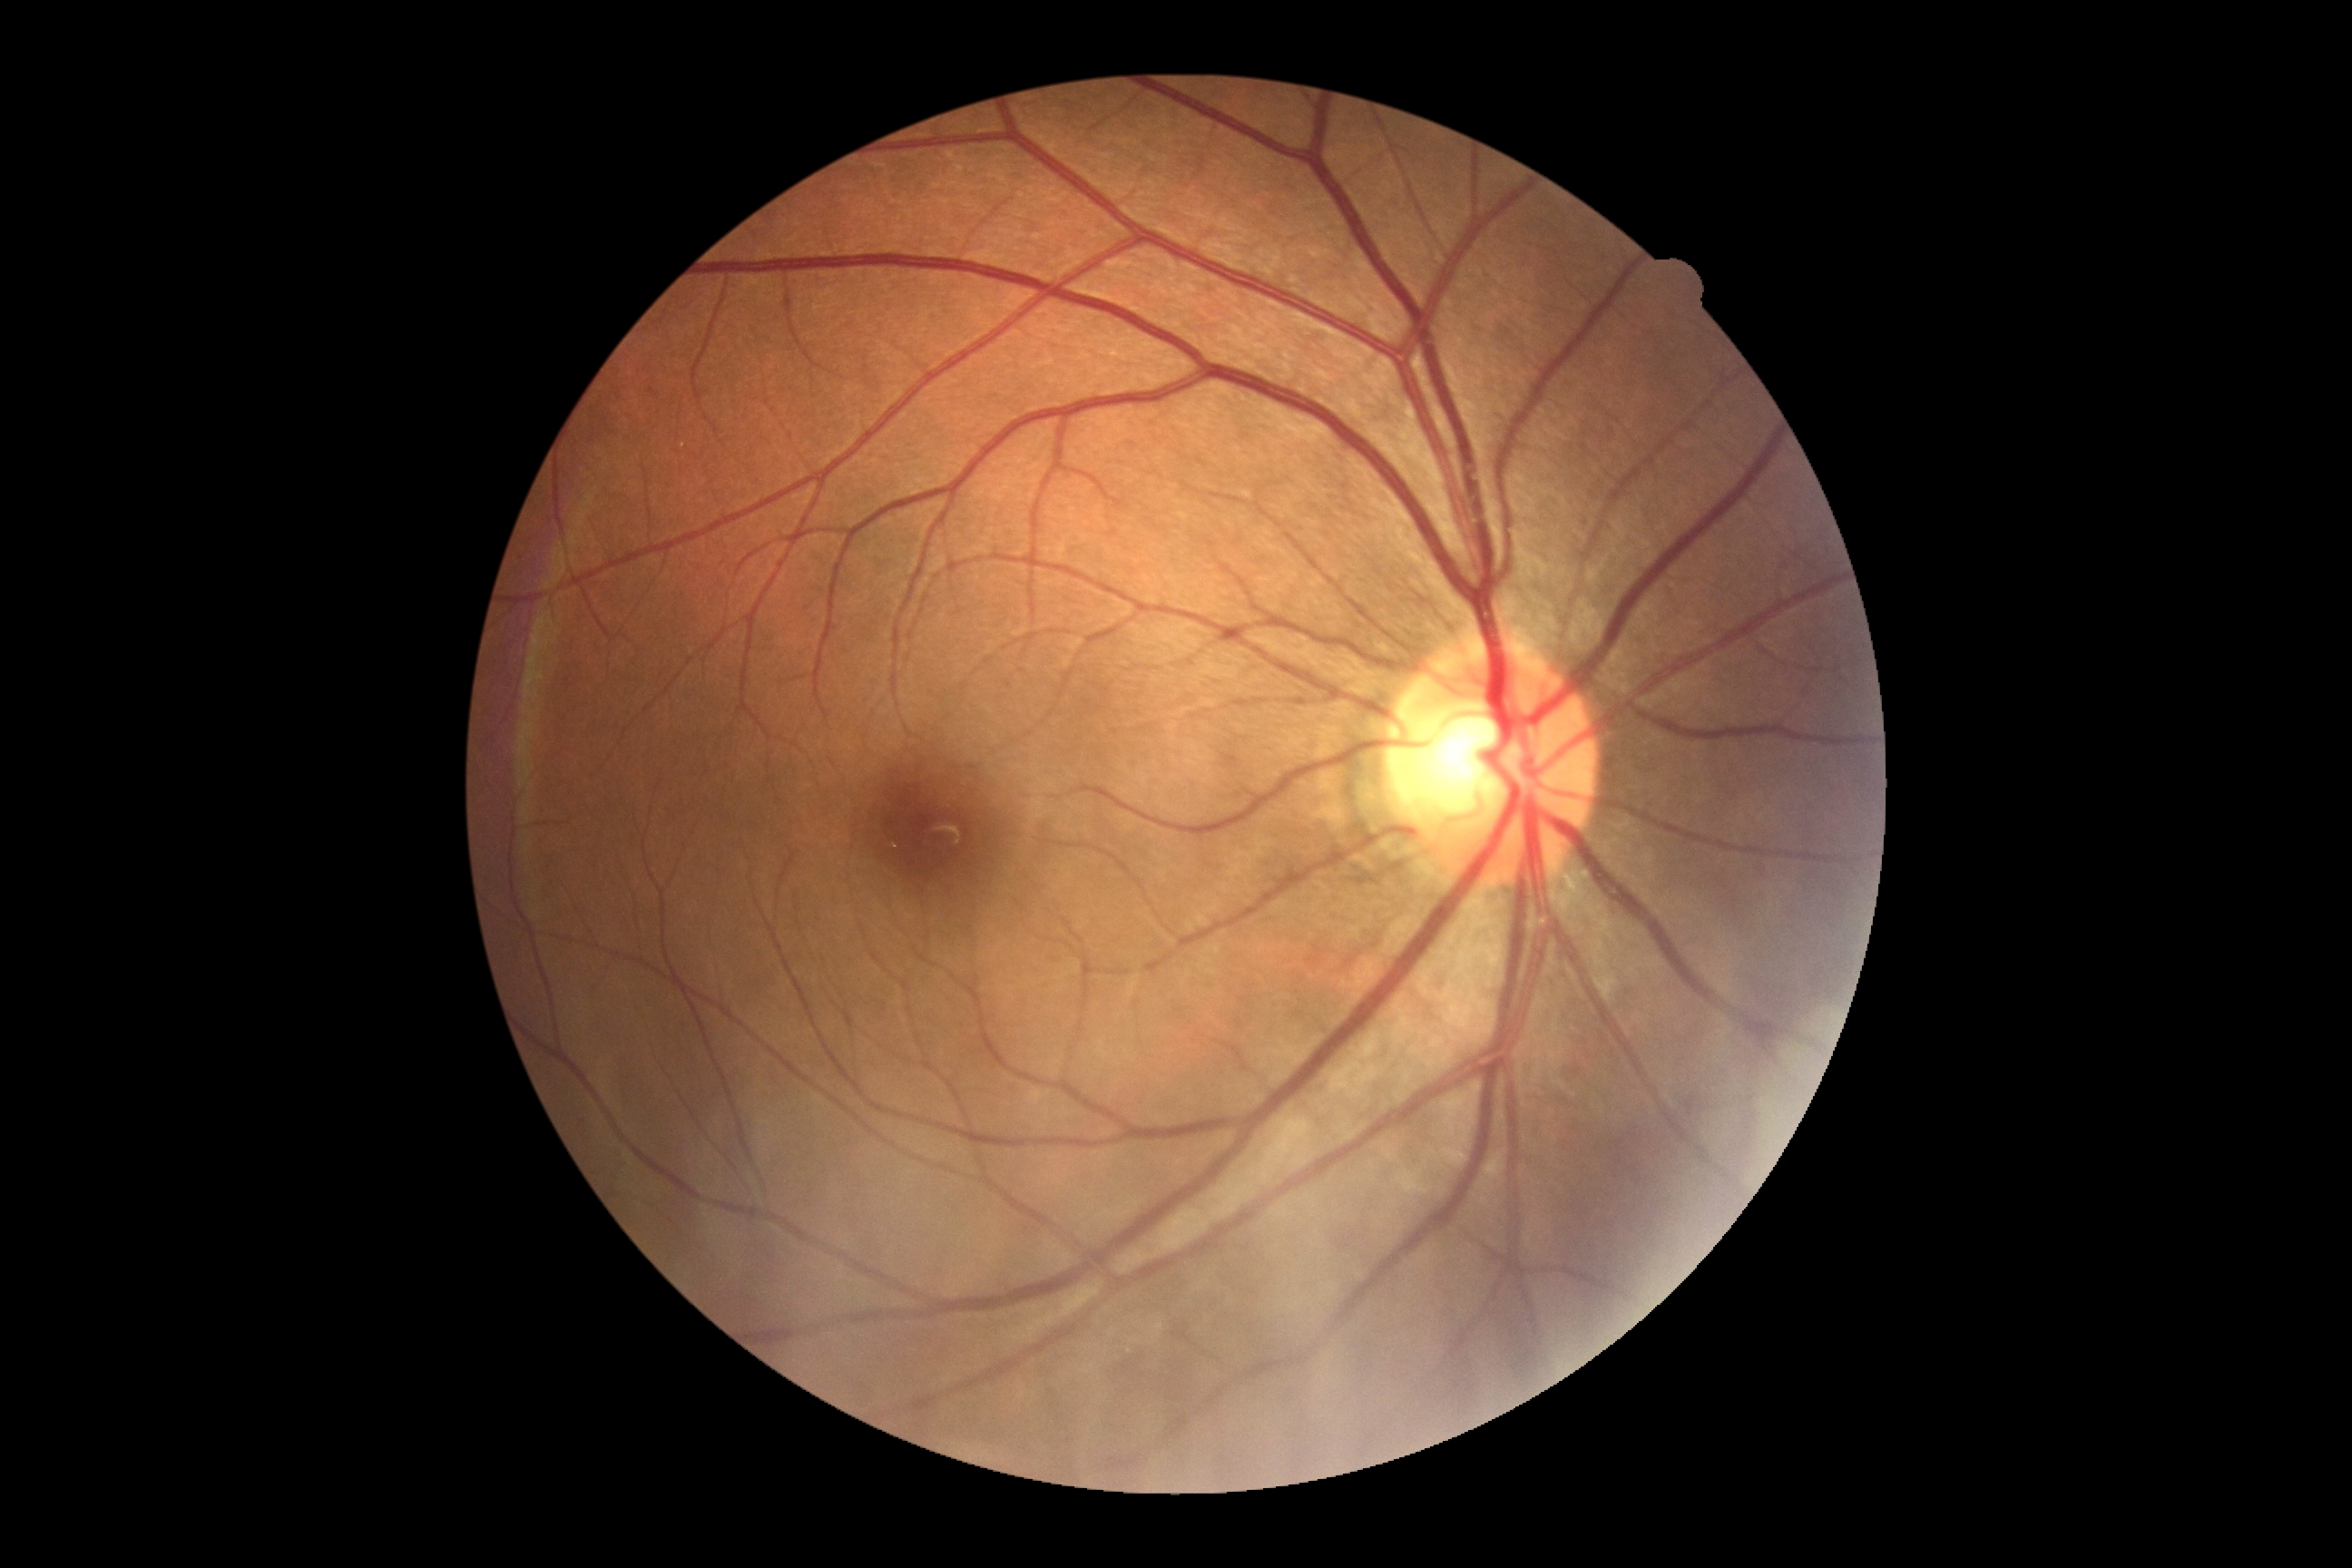
- retinopathy — no apparent retinopathy (grade 0)
- DR impression — no apparent DR